848x848, no pharmacologic dilation, graded on the modified Davis scale: 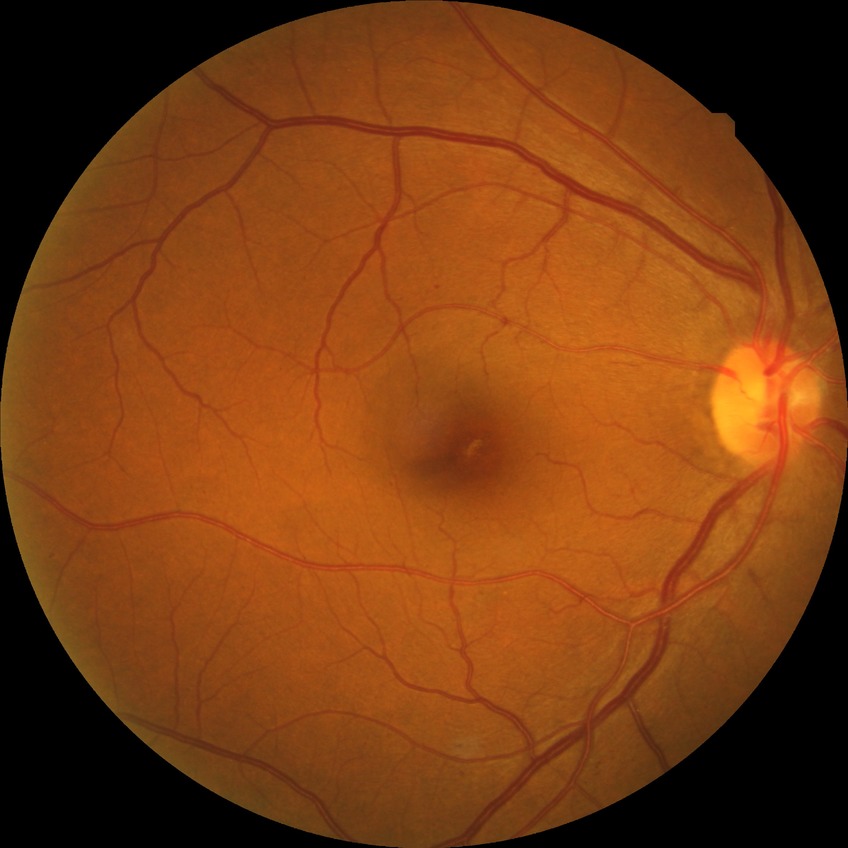

DR class = non-proliferative diabetic retinopathy; DR = SDR.